Image size 1380x1382, FOV: 45 degrees, color fundus photograph: 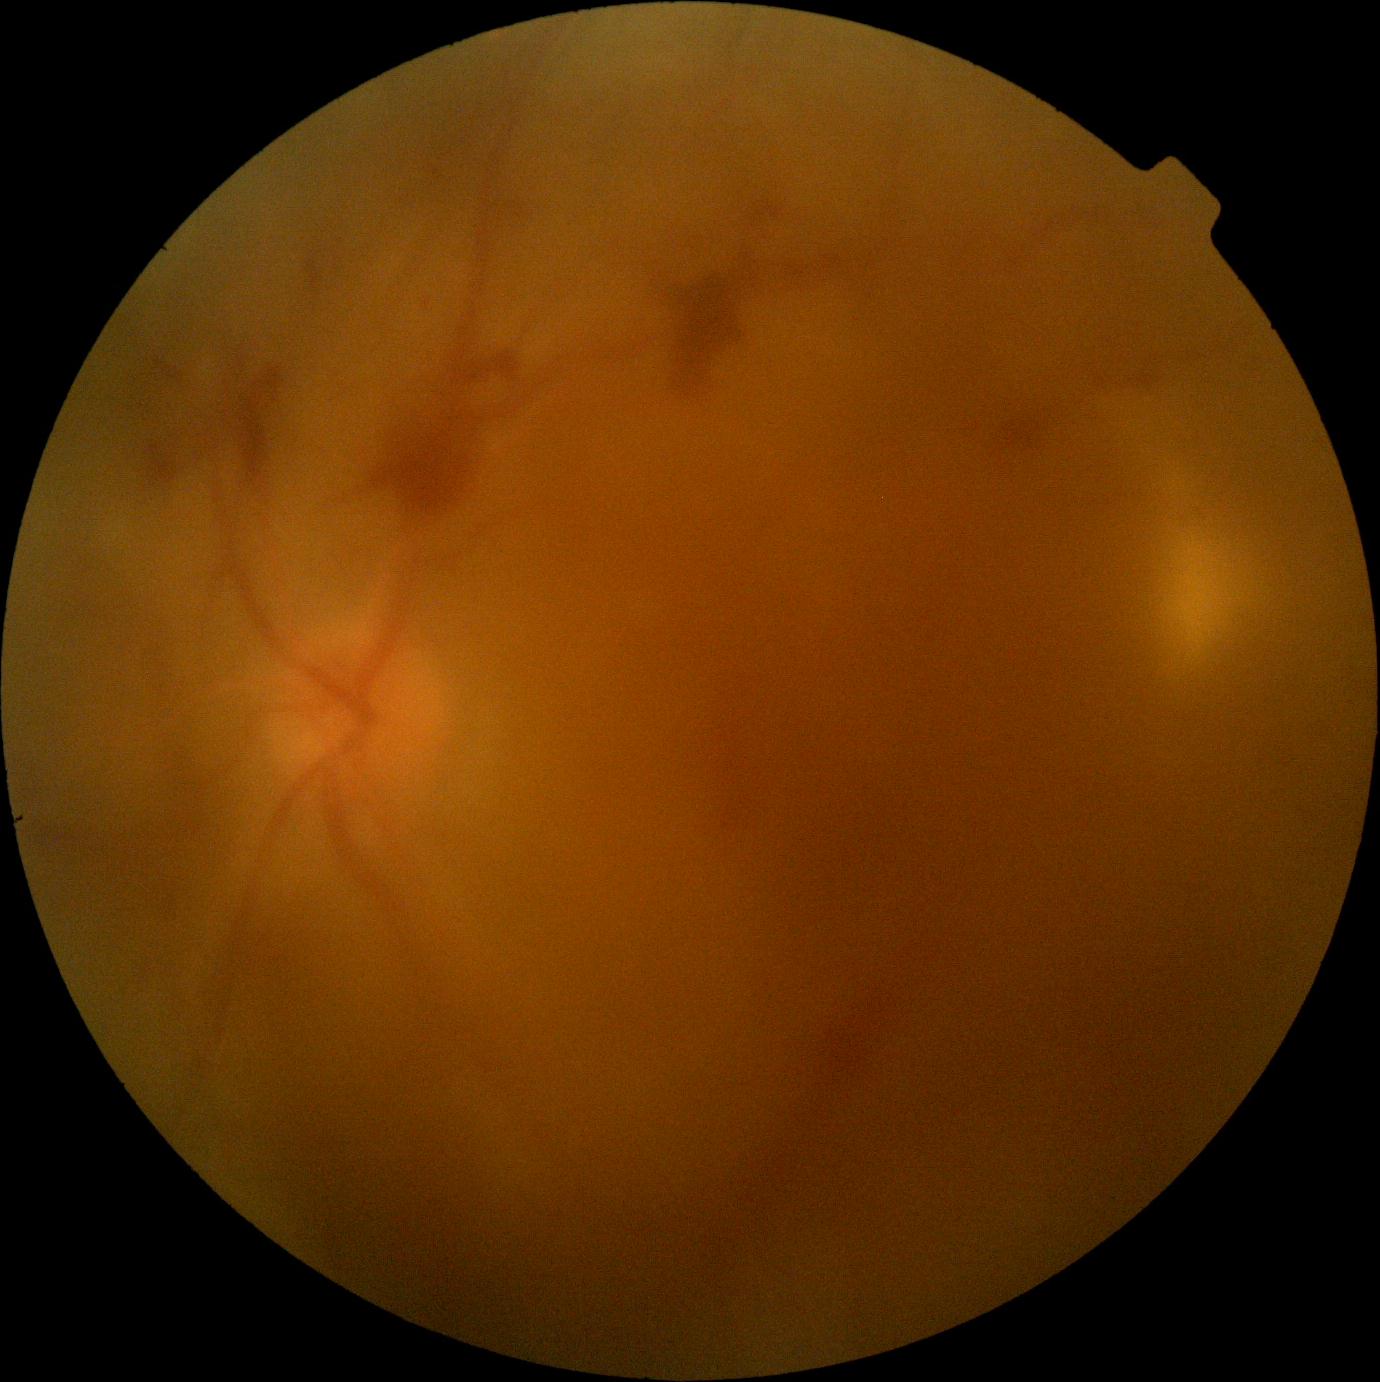

DR severity: 4